Fundus photo: 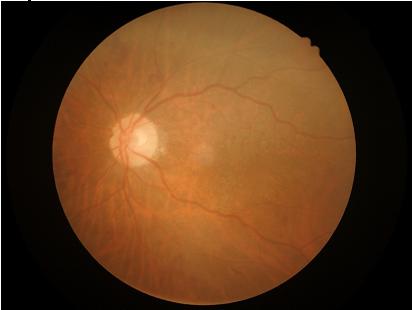 Vessels and details are hard to distinguish. Image quality is suboptimal. No noticeable blur. No over- or under-exposure.